Acquired with a NIDEK AFC-230; 45° field of view — 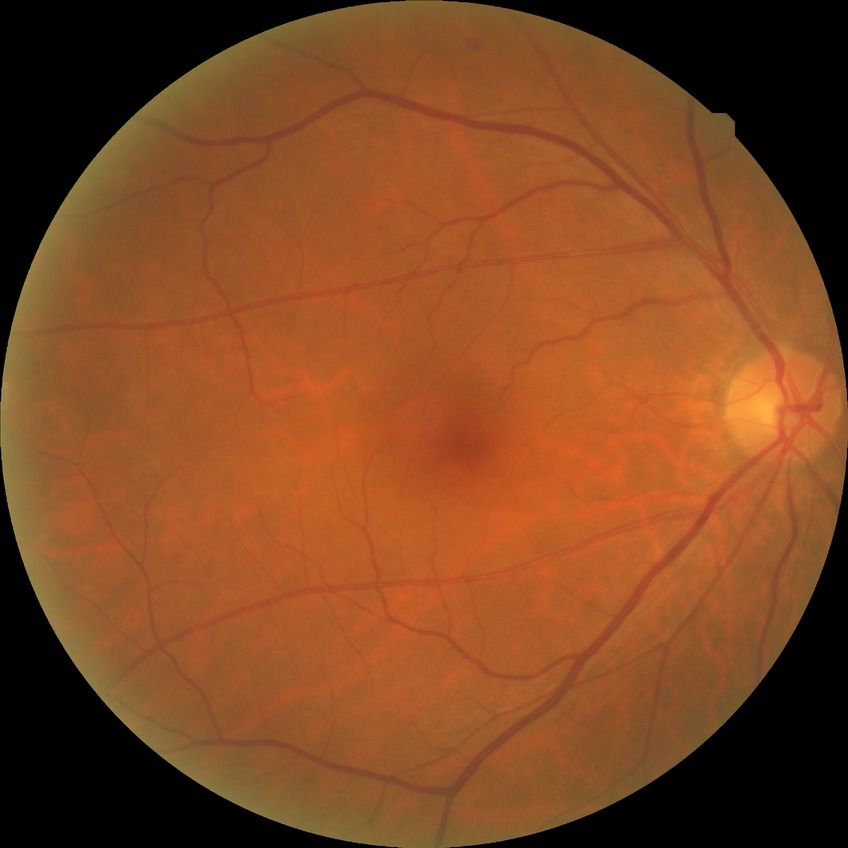 DR grade: NDR.